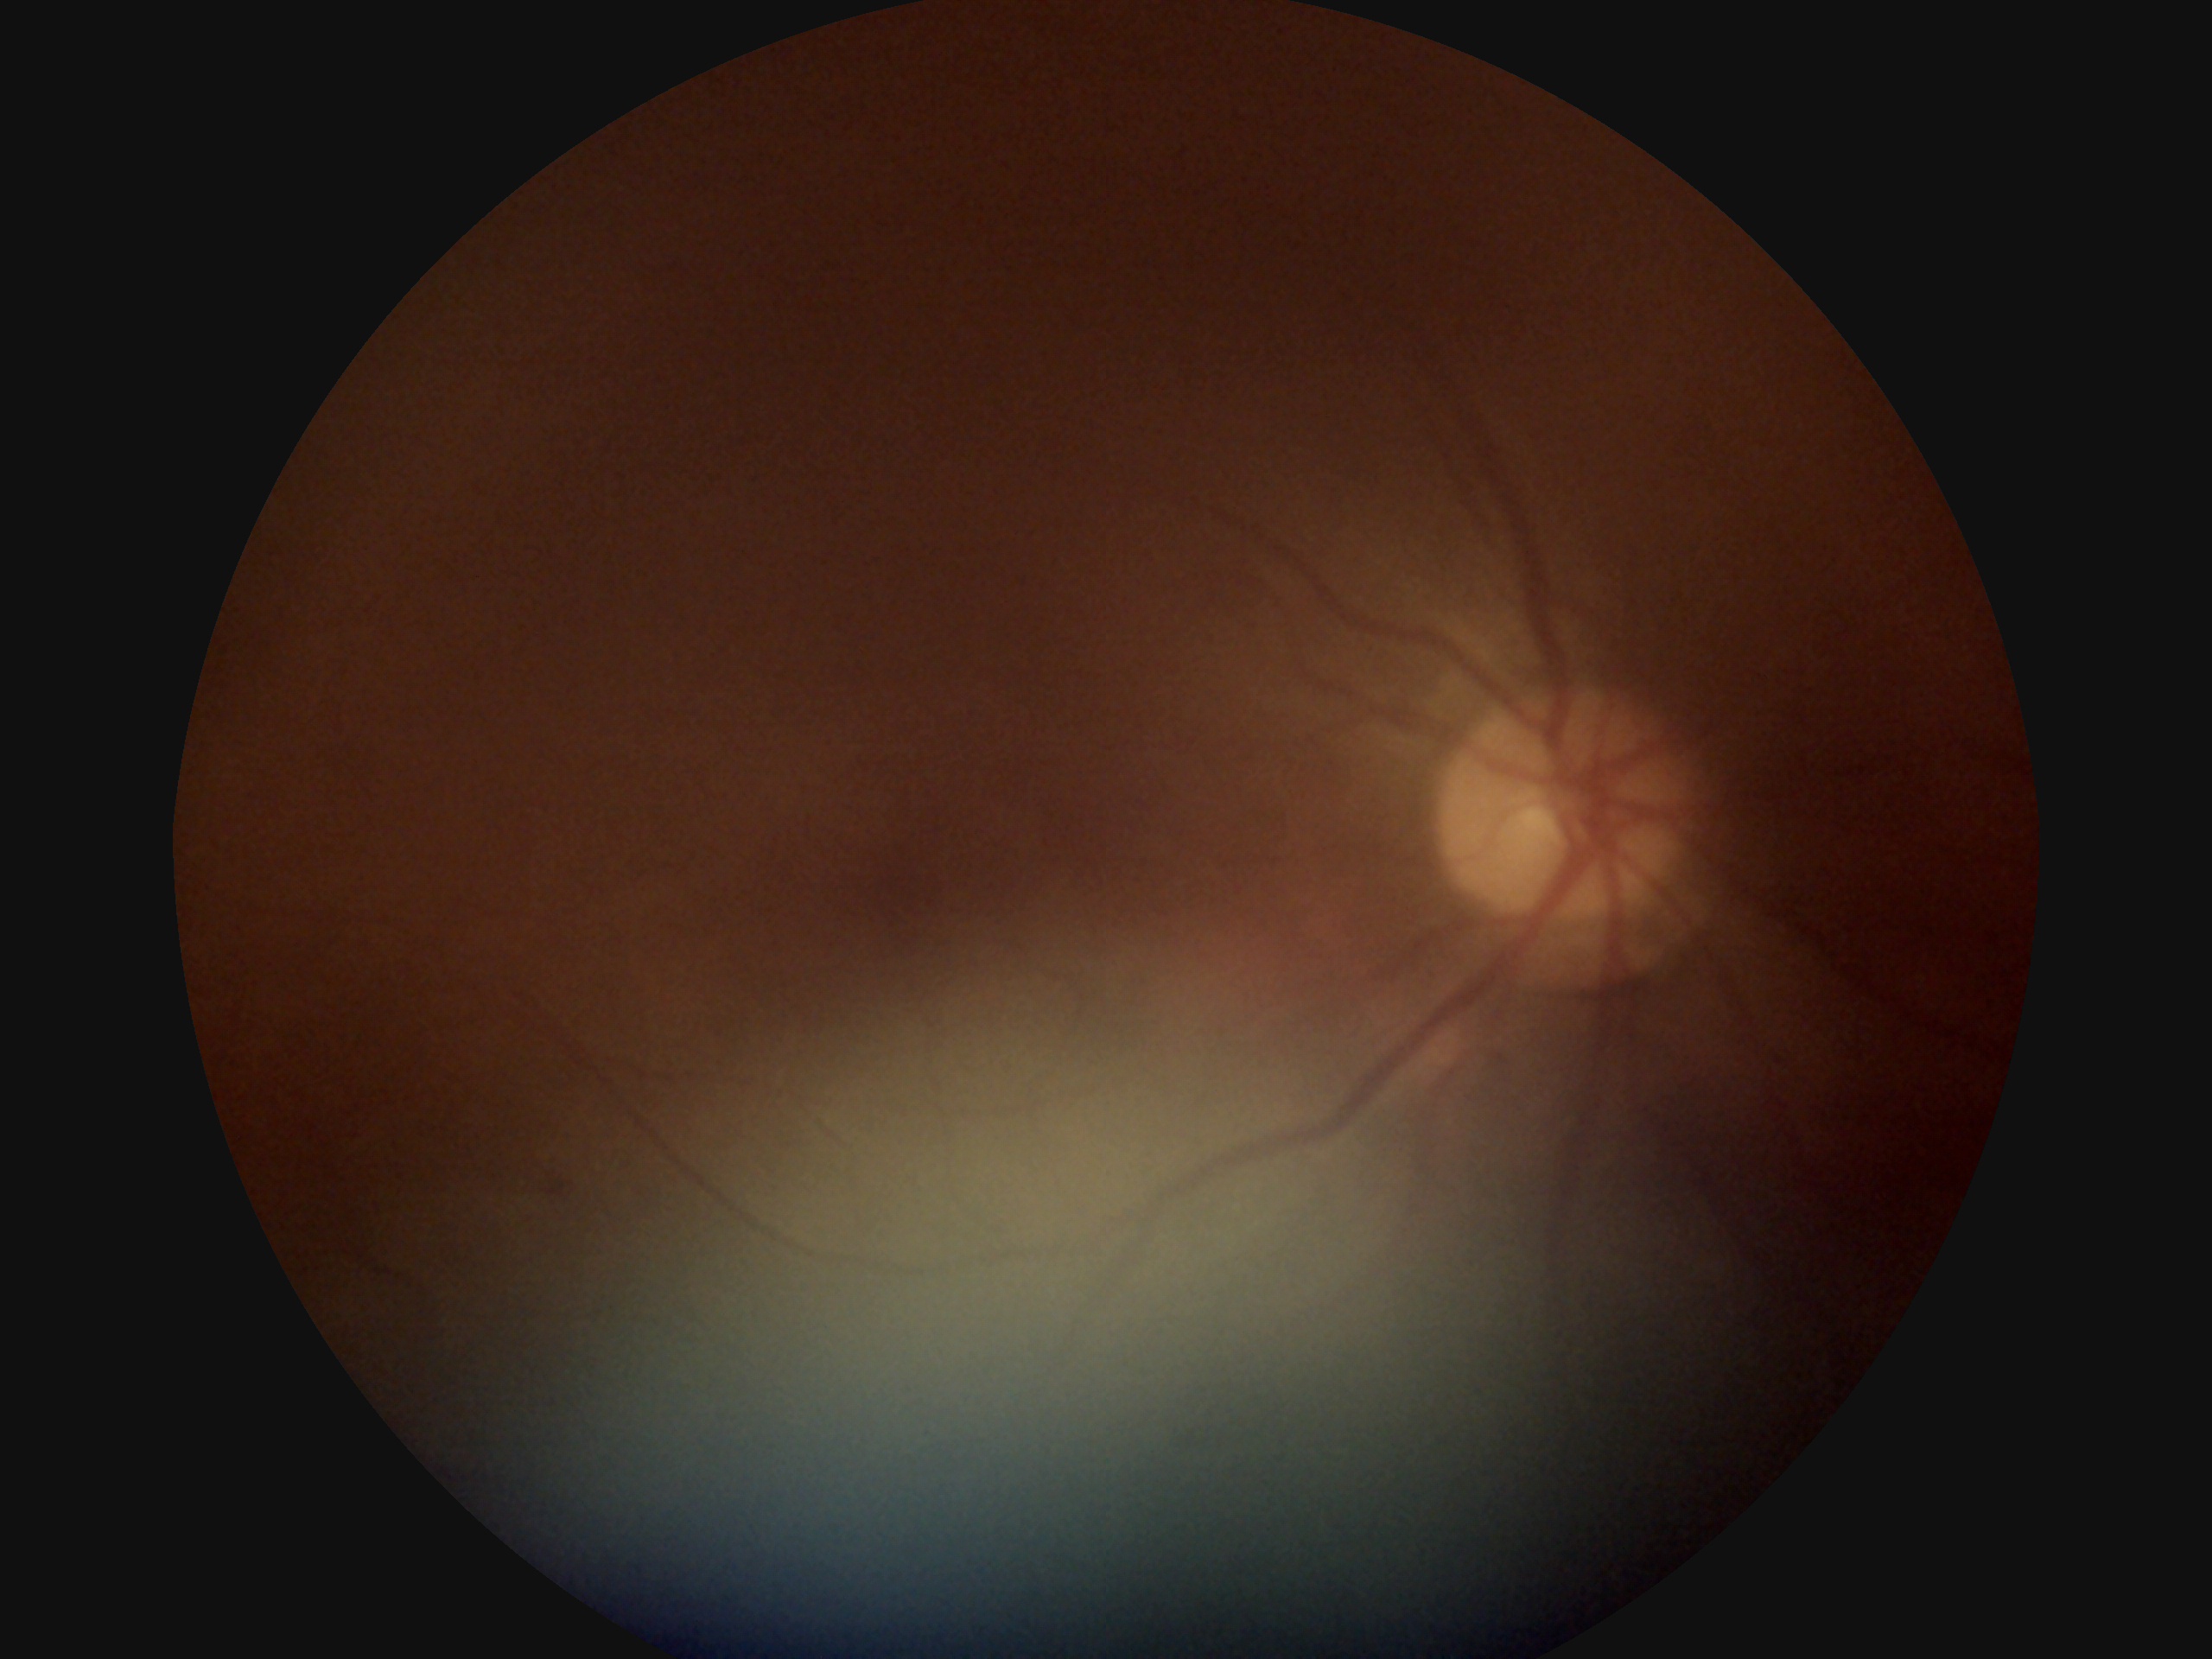
DR is grade 2 — more than just microaneurysms but less than severe NPDR.